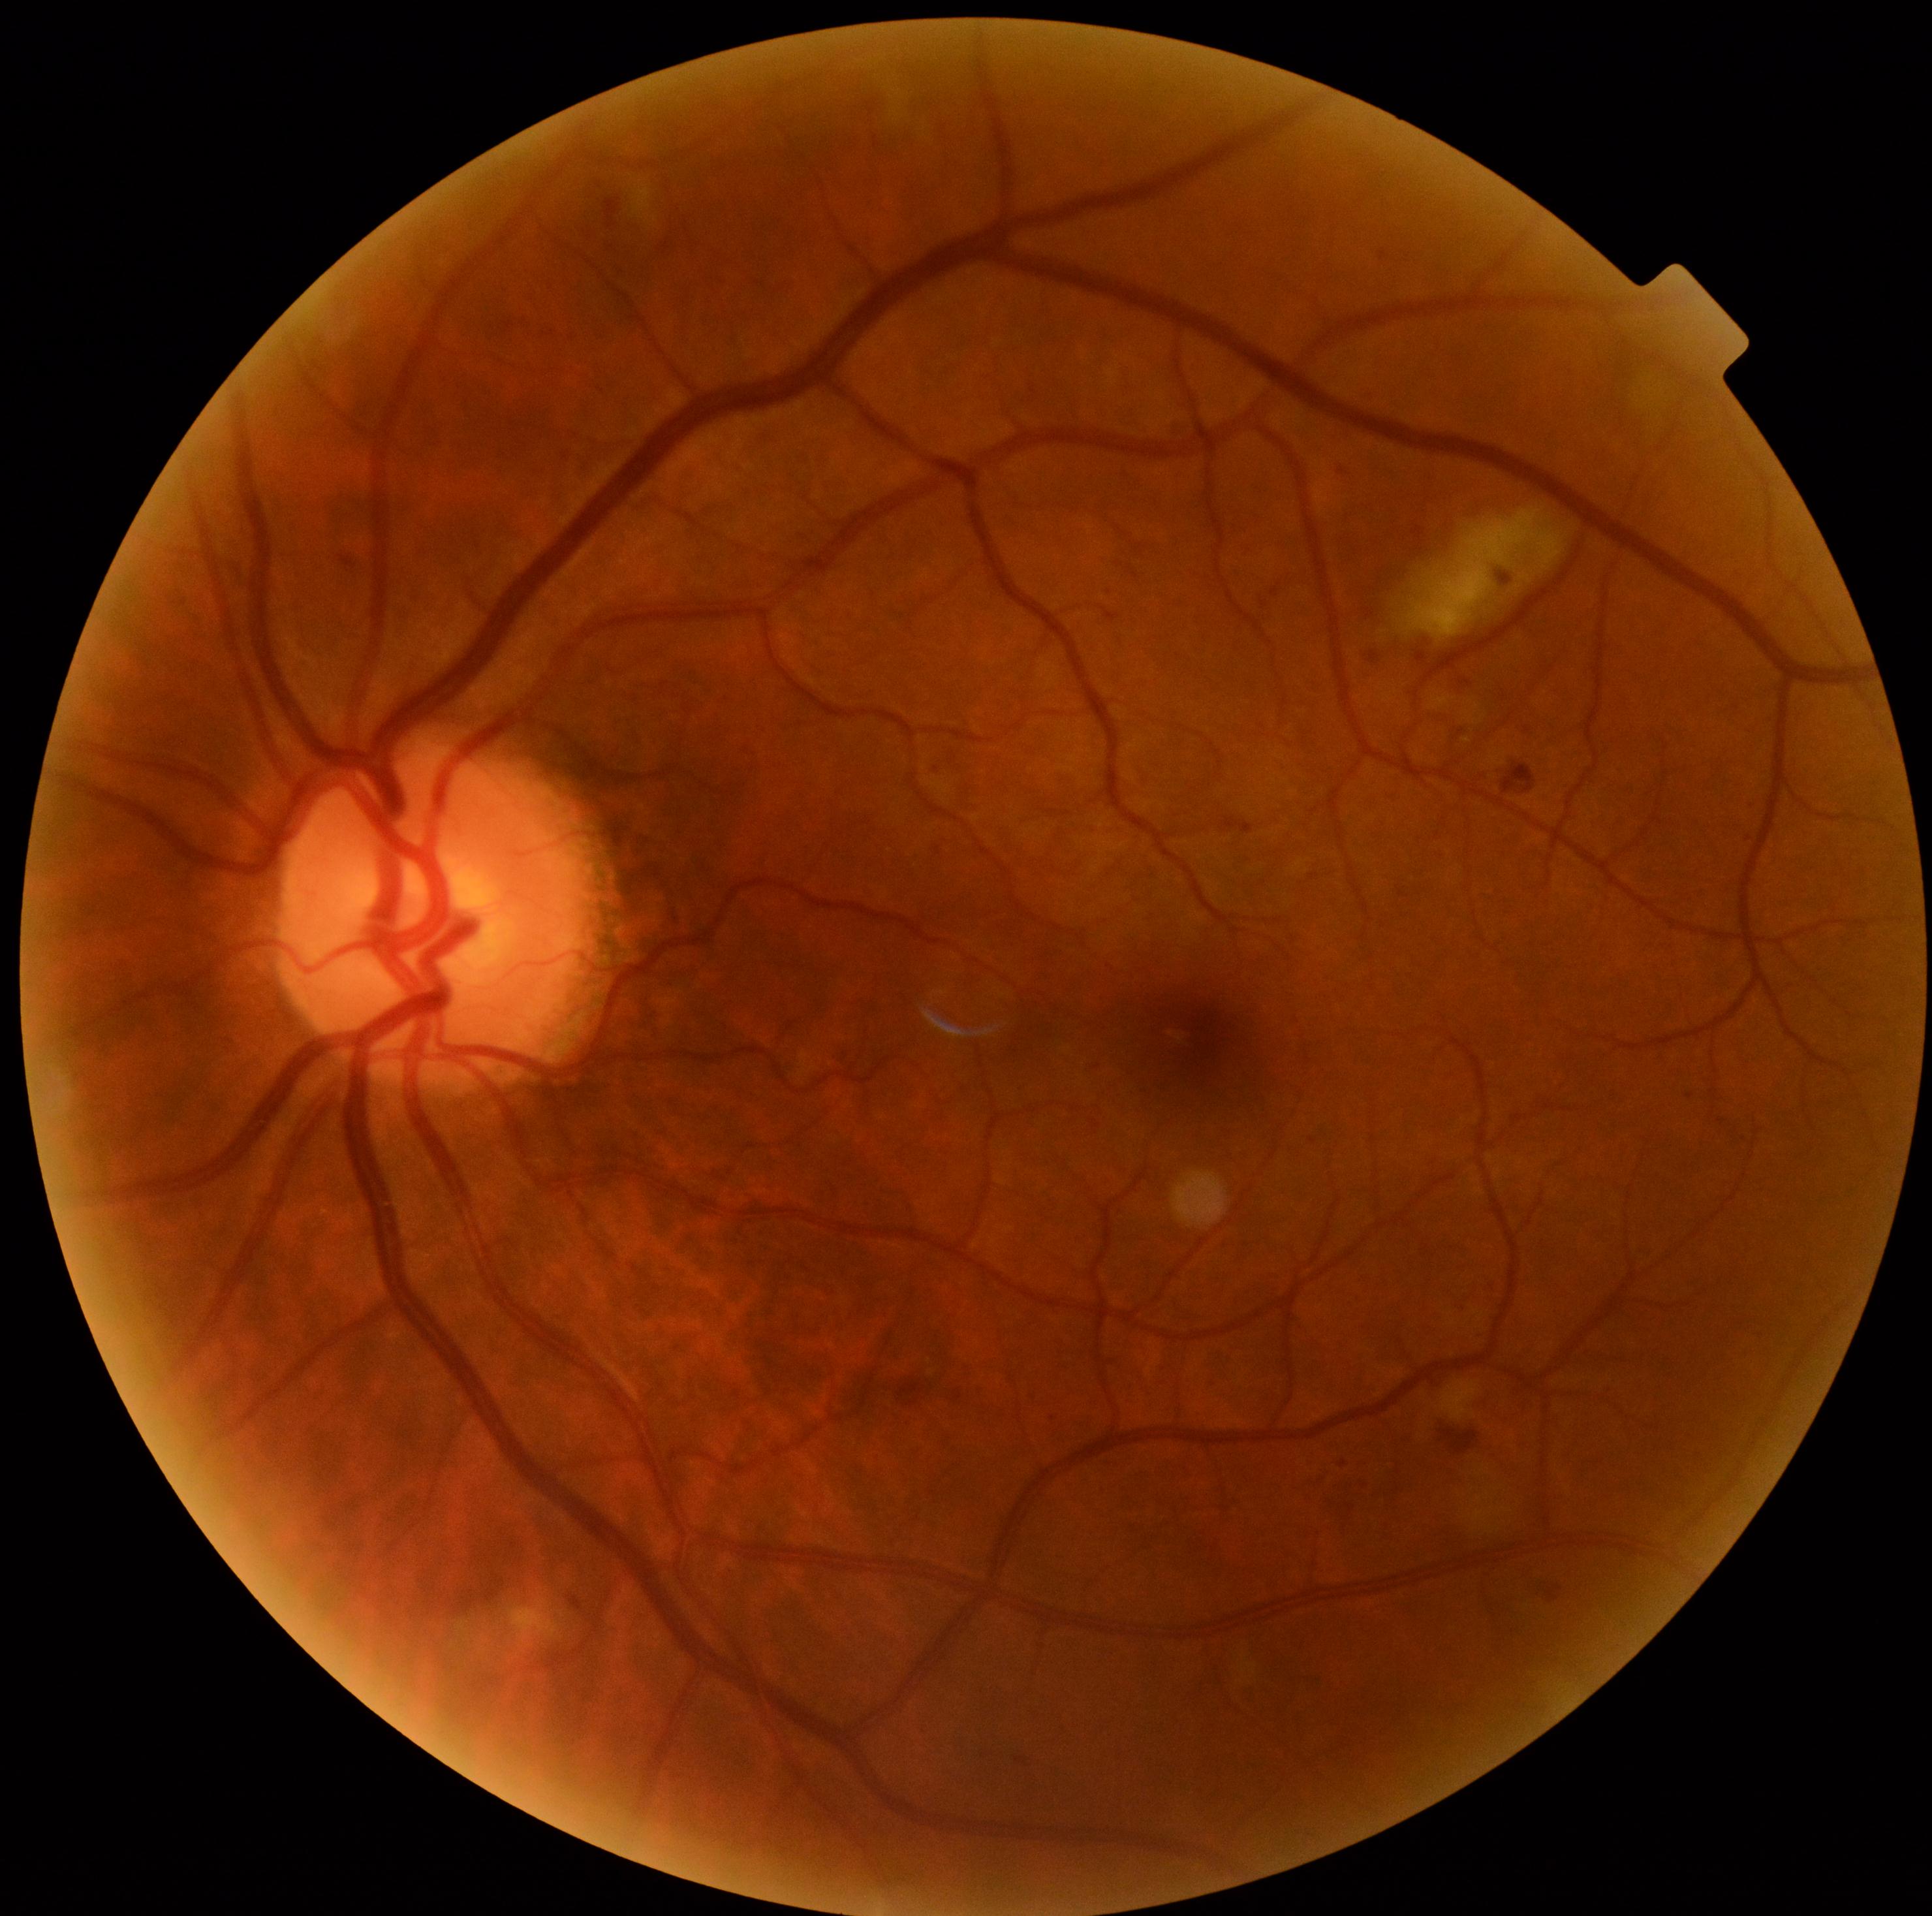
diabetic retinopathy: grade 2.